Image size 2350x1568:
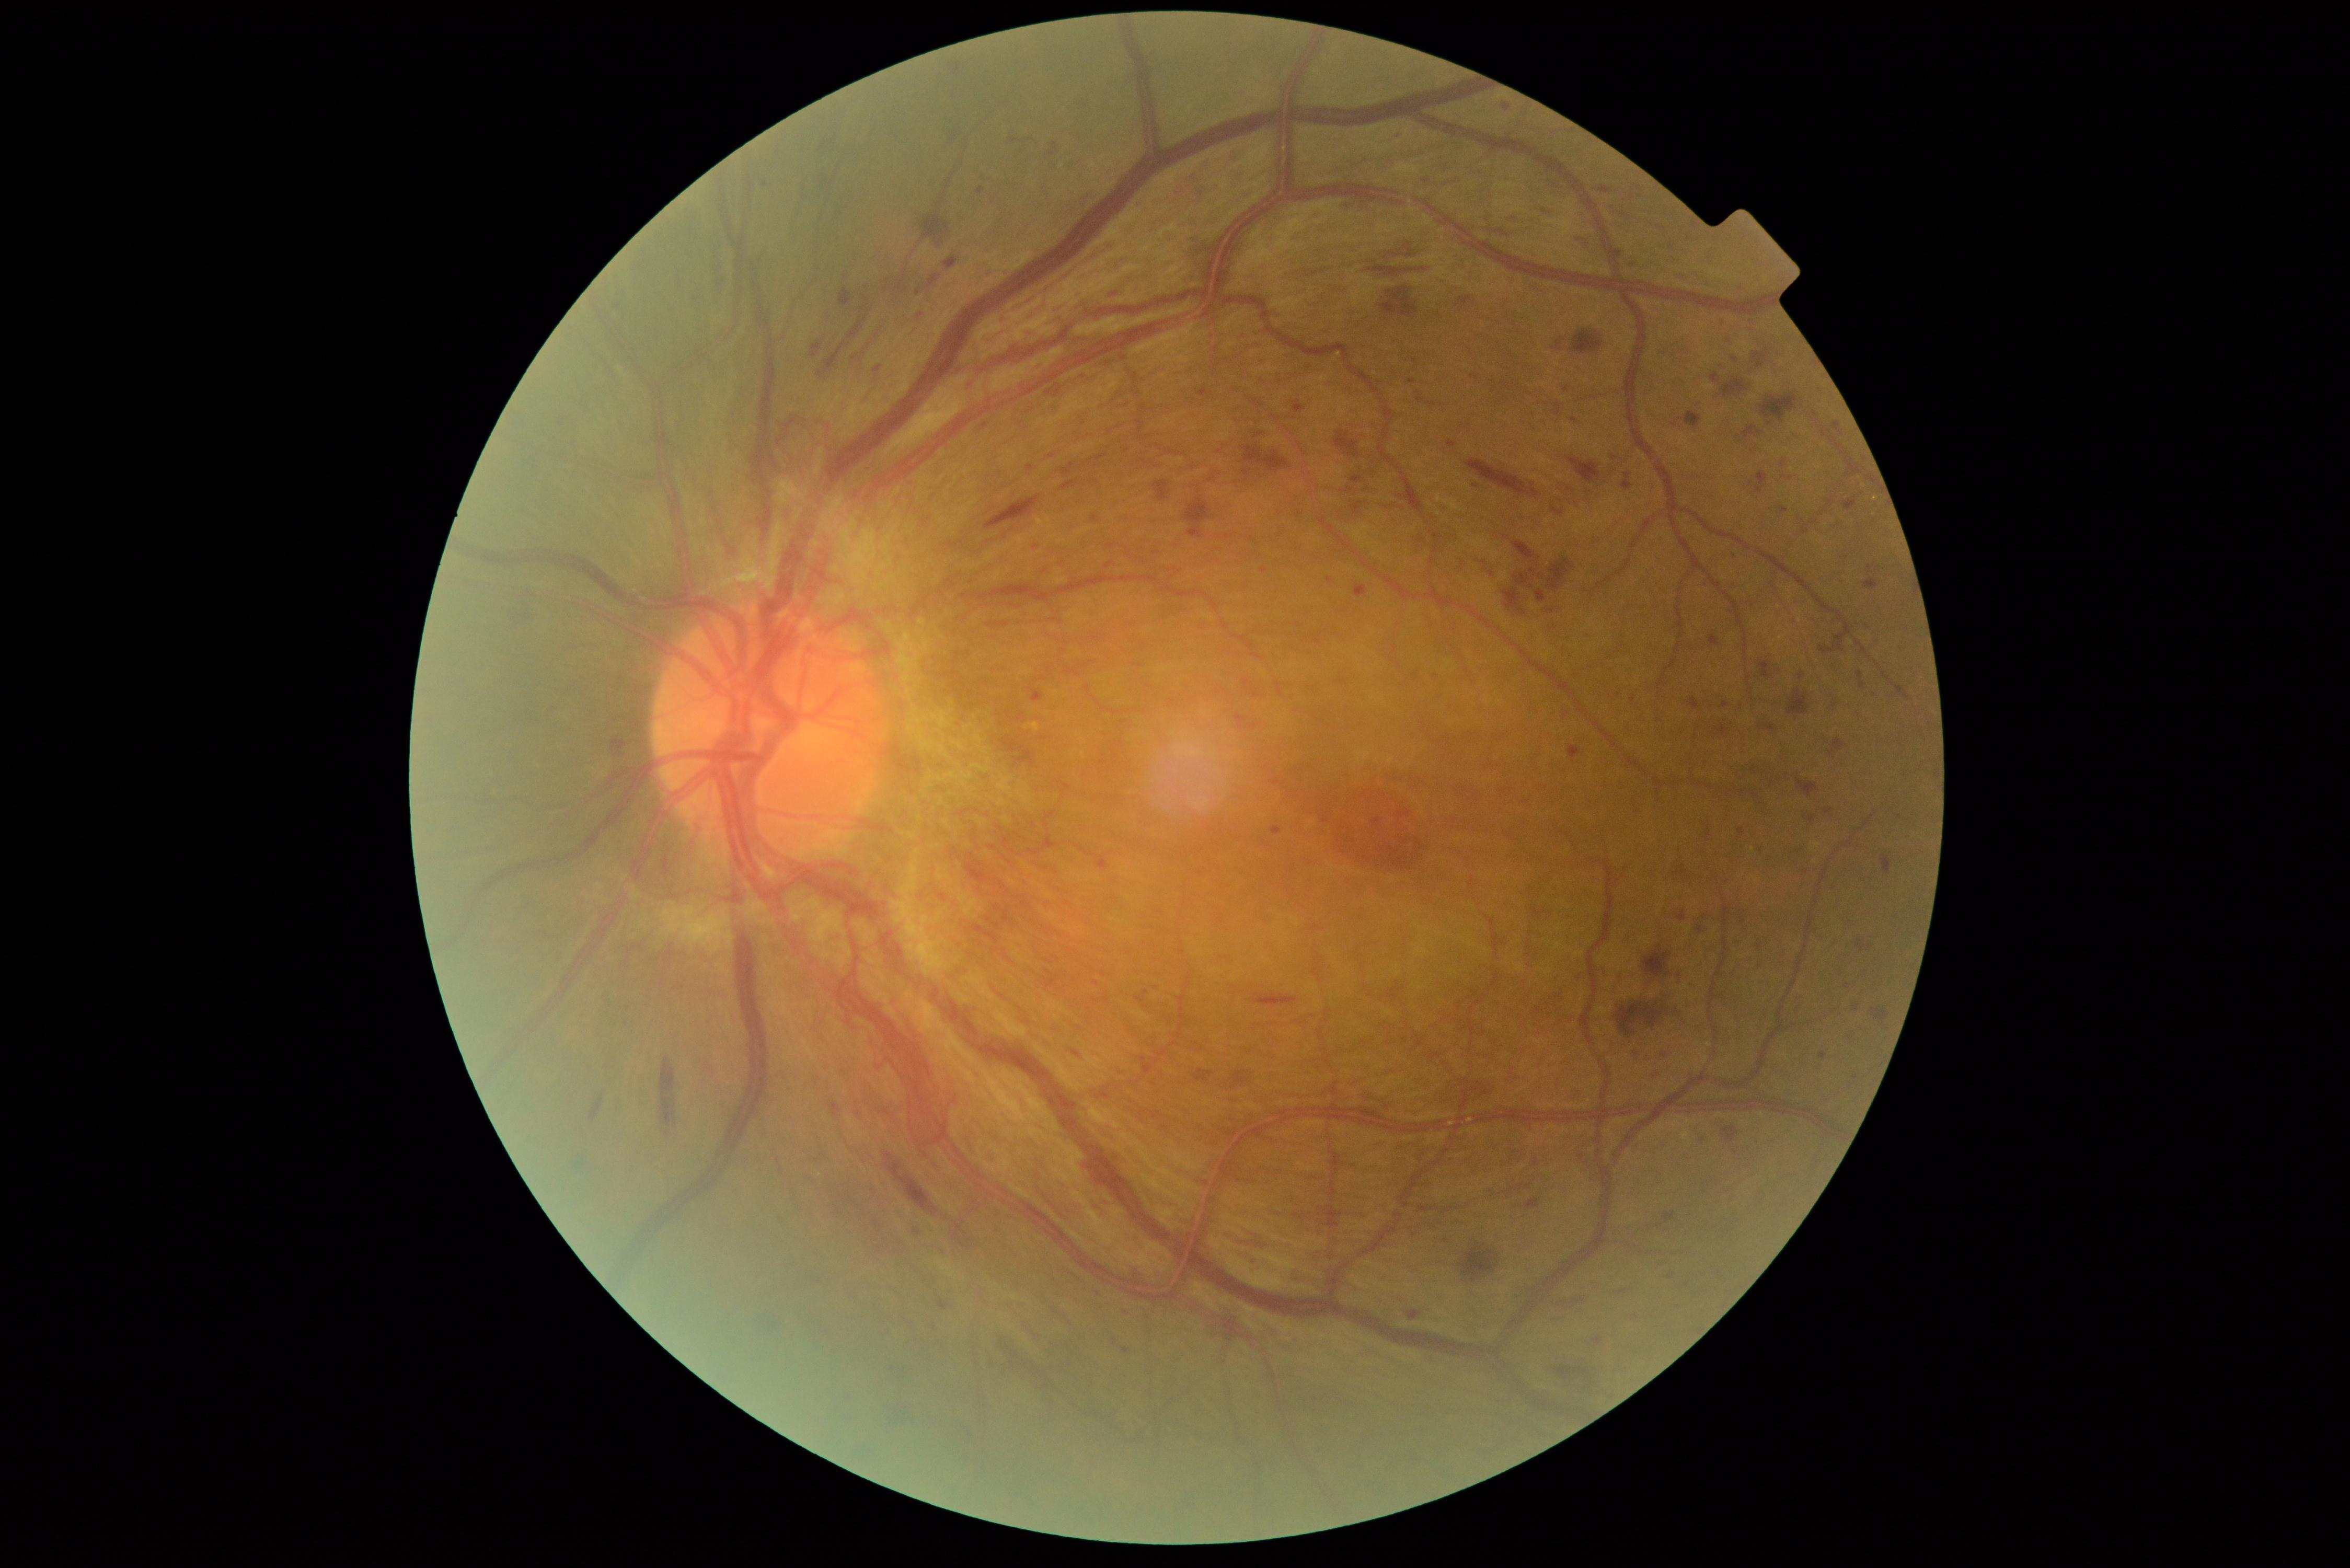 {"partial": true, "dr_grade": 4, "lesions": {"se": null, "ex": null, "he": [[1502, 214, 1517, 217], [1754, 352, 1768, 368], [1609, 1288, 1633, 1296], [1856, 940, 1874, 952], [1556, 1365, 1588, 1380], [858, 383, 877, 404], [1234, 1071, 1251, 1085], [1524, 1198, 1540, 1210], [1673, 418, 1681, 427], [1623, 473, 1632, 490], [710, 220, 728, 307], [1760, 394, 1798, 425], [1252, 995, 1296, 1009], [1685, 411, 1702, 430], [1760, 724, 1775, 731], [1503, 559, 1574, 616], [1569, 456, 1601, 482], [1485, 566, 1494, 572], [1673, 971, 1680, 991], [1554, 338, 1564, 352]], "ma": [[1739, 827, 1745, 835], [1780, 506, 1788, 514], [1625, 480, 1630, 490], [1675, 910, 1686, 923], [1716, 724, 1730, 736], [1689, 699, 1699, 709], [831, 1102, 839, 1113], [938, 1302, 949, 1309]], "ma_small_centers": [[1264, 571], [935, 1328], [1050, 393], [1095, 519], [918, 293], [1699, 930], [1425, 181], [1507, 107], [1739, 286]]}}